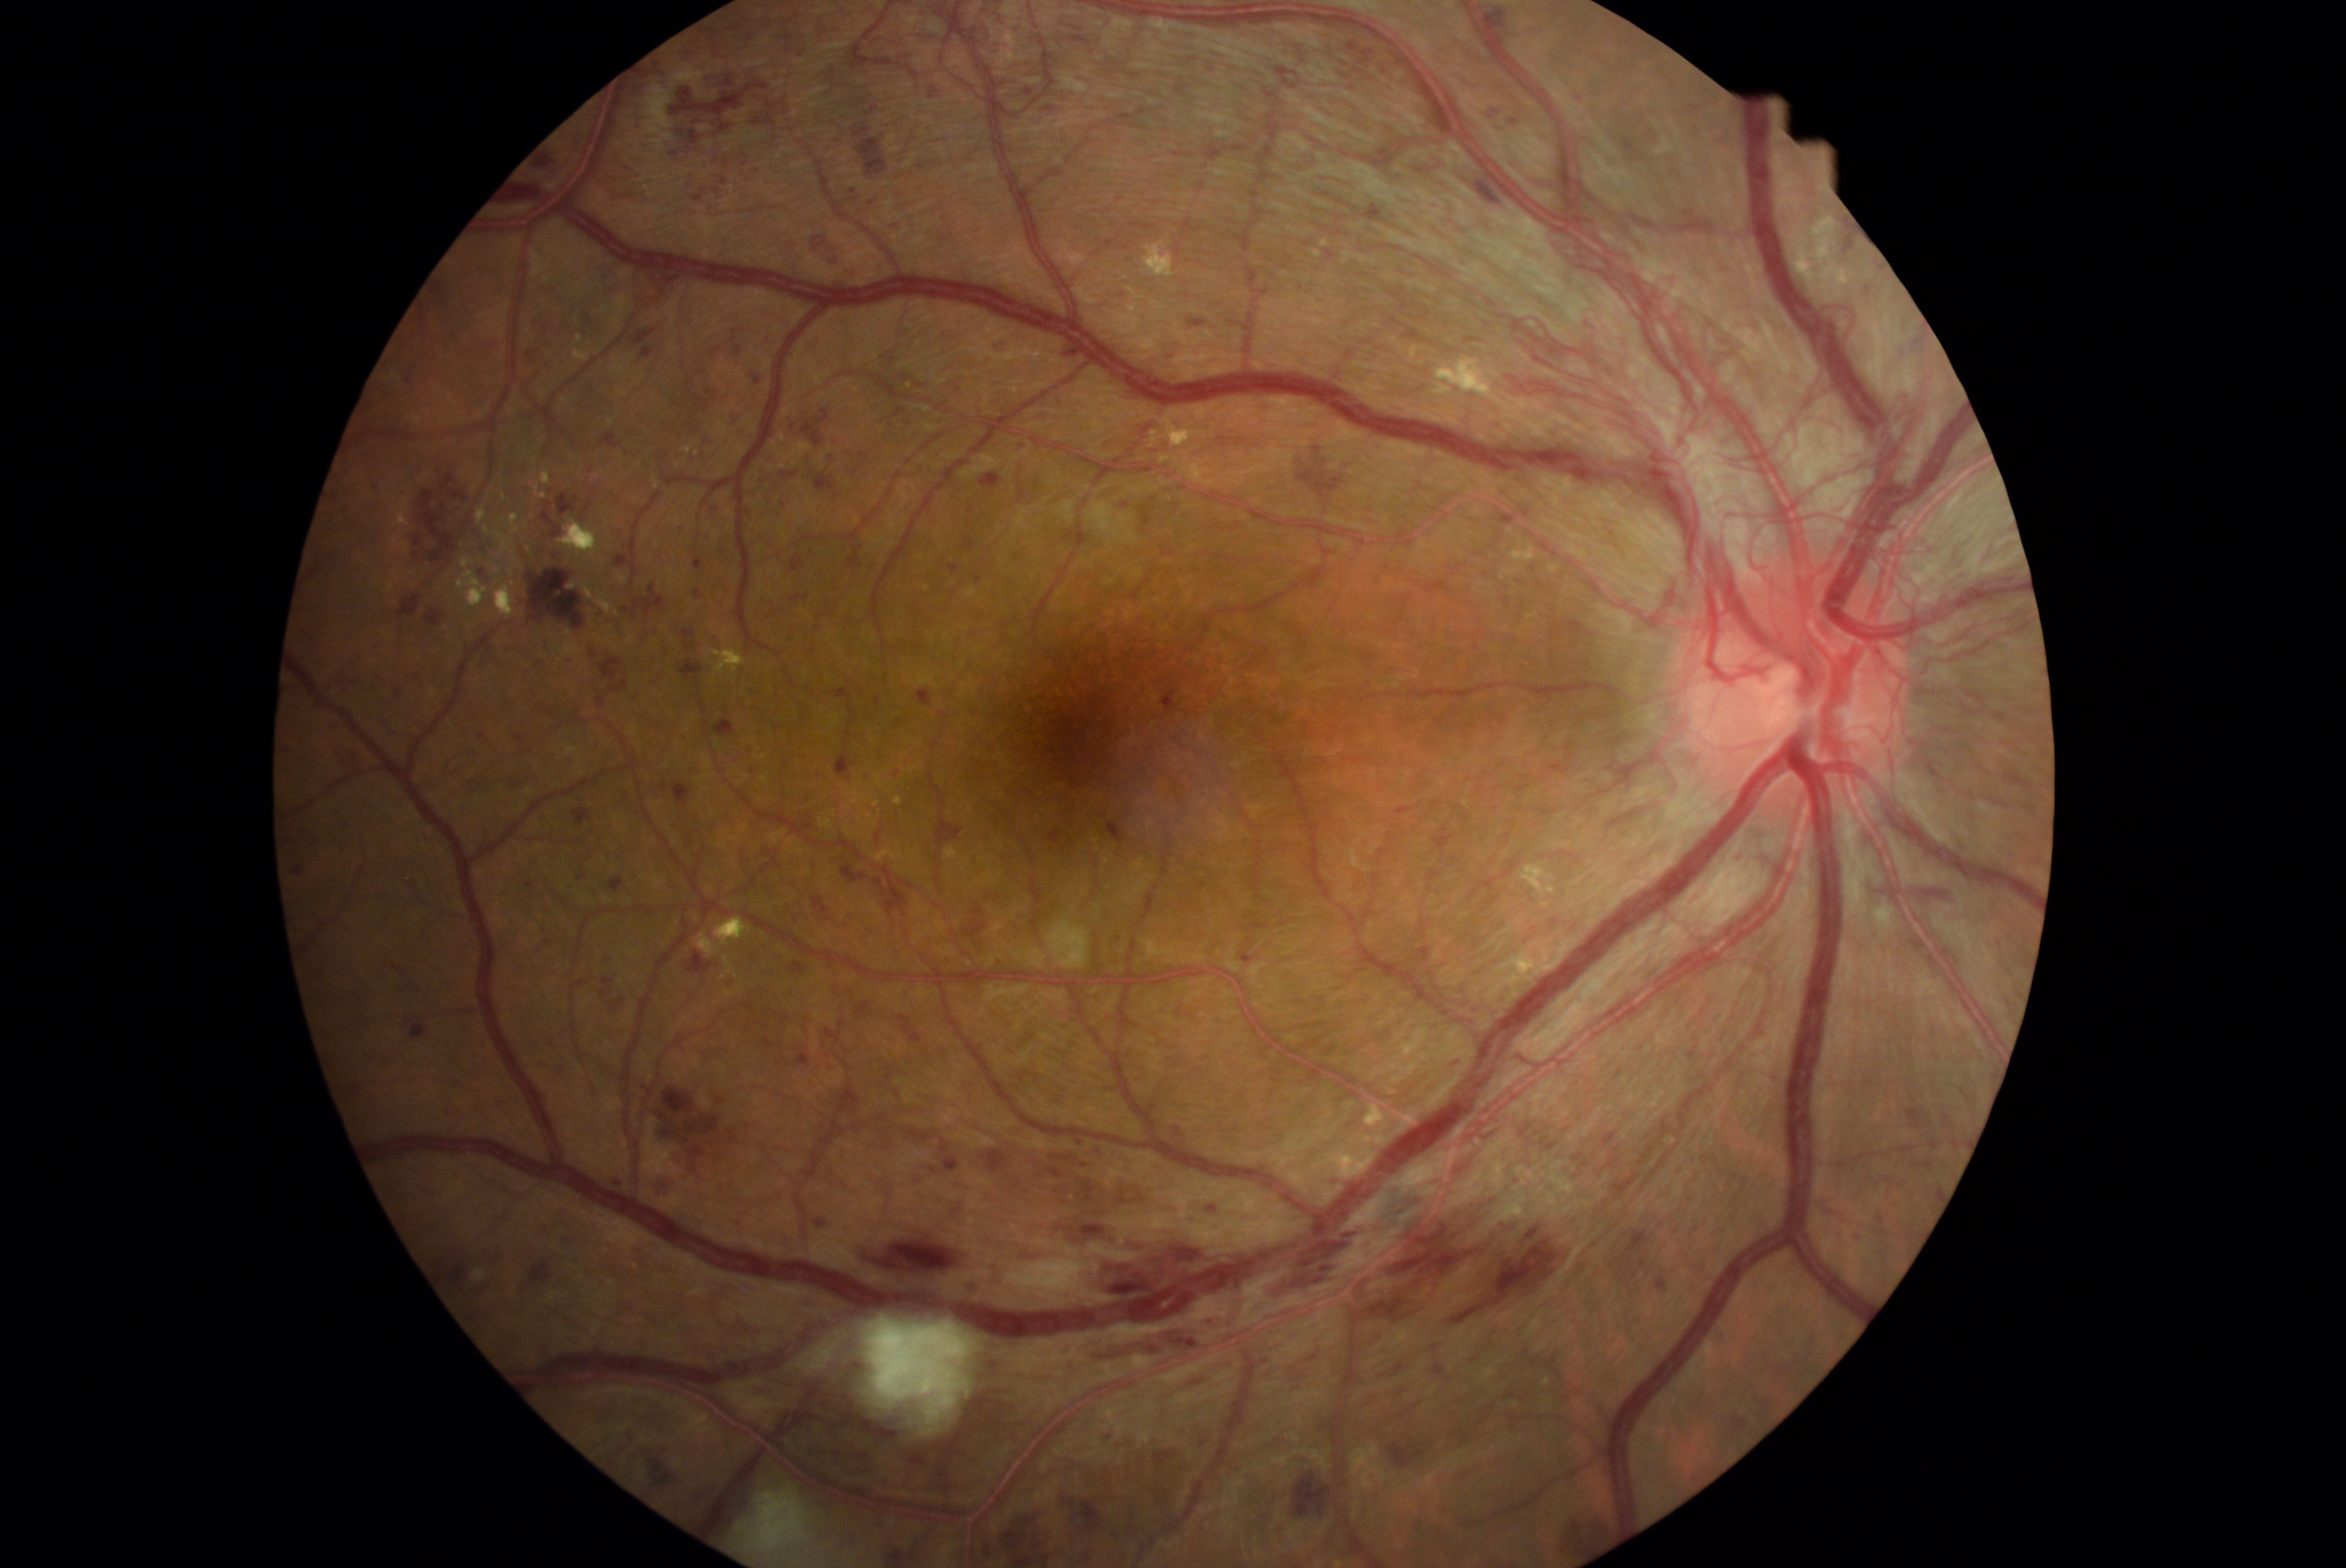
Diabetic retinopathy (DR): 4/4
Representative lesions:
hemorrhages (HEs) (more not shown): <bbox>292, 866, 305, 876</bbox> | <bbox>648, 269, 689, 302</bbox> | <bbox>603, 283, 626, 296</bbox> | <bbox>677, 526, 689, 532</bbox> | <bbox>1189, 319, 1205, 328</bbox> | <bbox>854, 126, 871, 137</bbox> | <bbox>617, 789, 642, 815</bbox> | <bbox>844, 266, 860, 280</bbox> | <bbox>559, 1232, 575, 1247</bbox> | <bbox>1191, 427, 1263, 465</bbox> | <bbox>1922, 1181, 1942, 1207</bbox> | <bbox>1080, 1319, 1219, 1360</bbox> | <bbox>1061, 90, 1070, 101</bbox> | <bbox>727, 407, 755, 441</bbox> | <bbox>619, 529, 625, 539</bbox> | <bbox>644, 60, 667, 78</bbox> | <bbox>482, 339, 501, 357</bbox>
HEs (small, approximate centers) near (x=830, y=459) | (x=1947, y=1175) | (x=482, y=784)